60° field of view; portable fundus photograph.
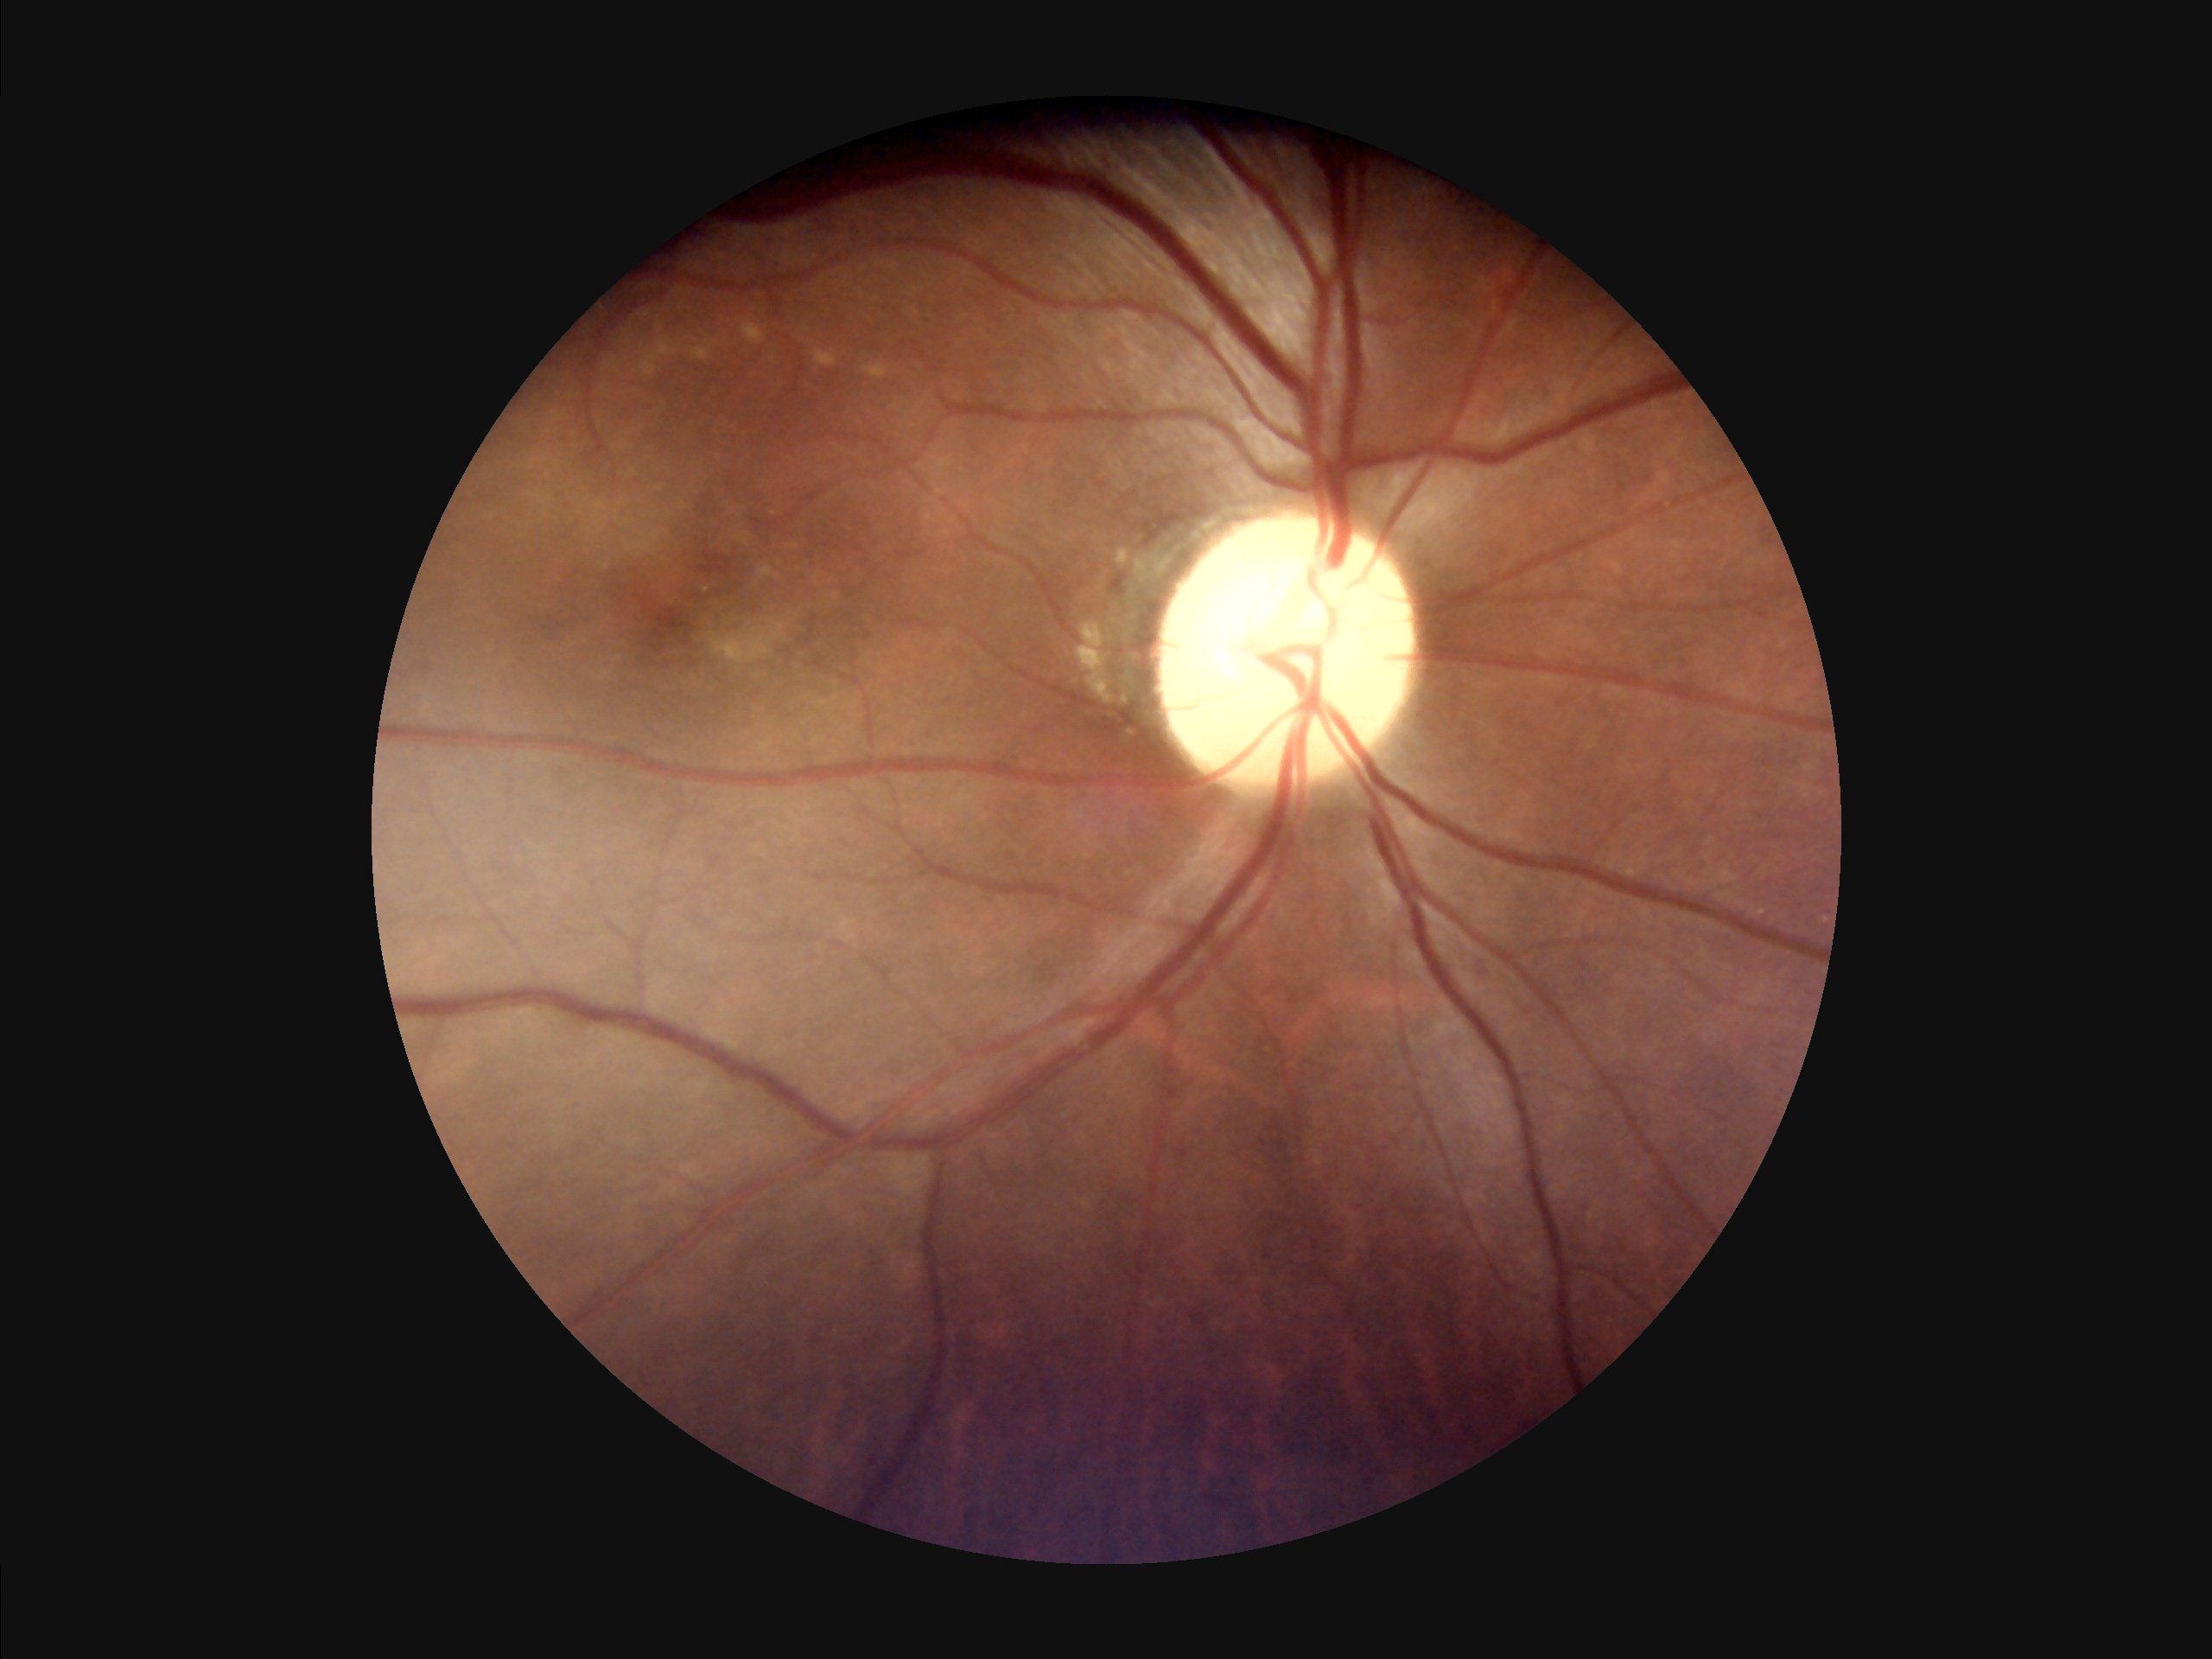
No noticeable blur. Acceptable image quality.